CFP, without pupil dilation, acquired with a NIDEK AFC-230, 848x848, DR severity per modified Davis staging.
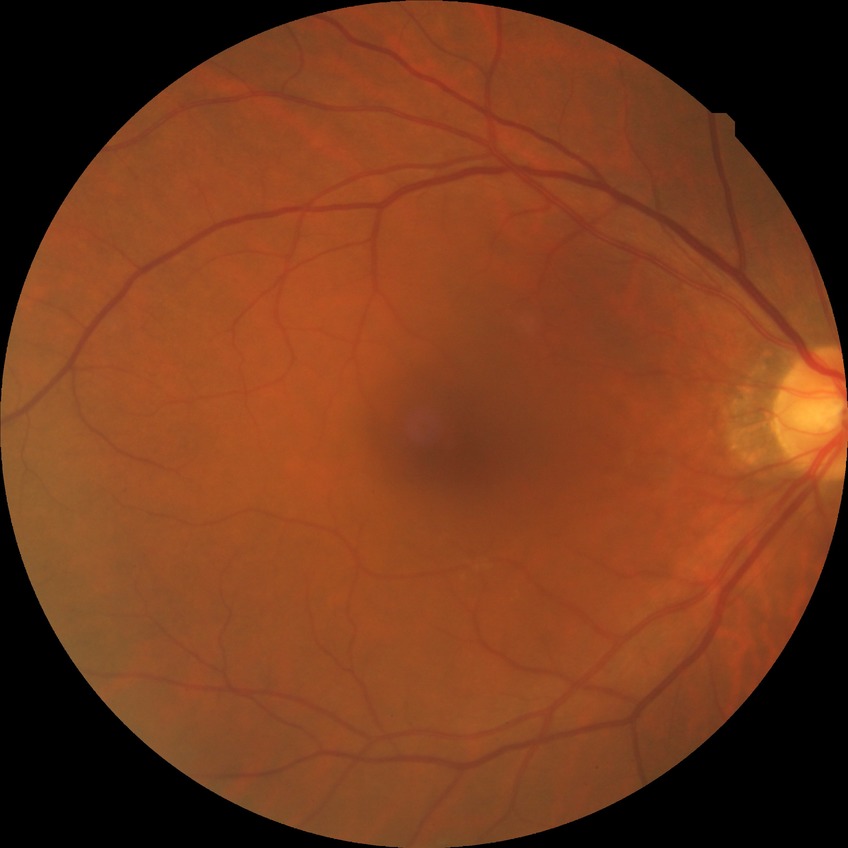

Modified Davis grading: no diabetic retinopathy.